FOV: 45 degrees · modified Davis classification:
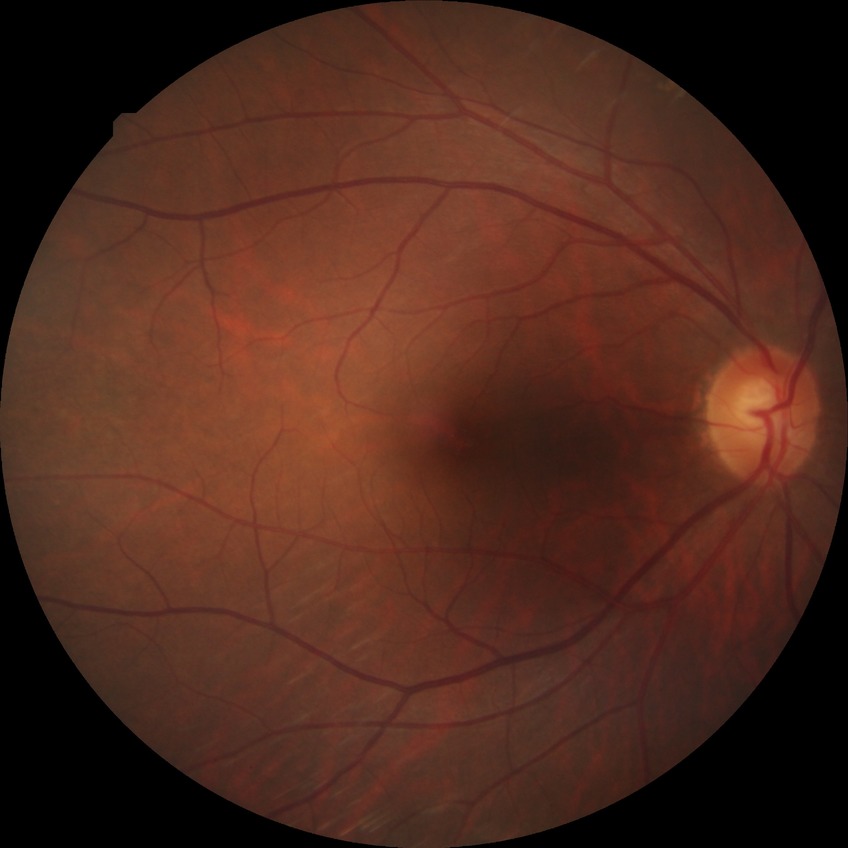

diabetic retinopathy (DR)=NDR (no diabetic retinopathy).